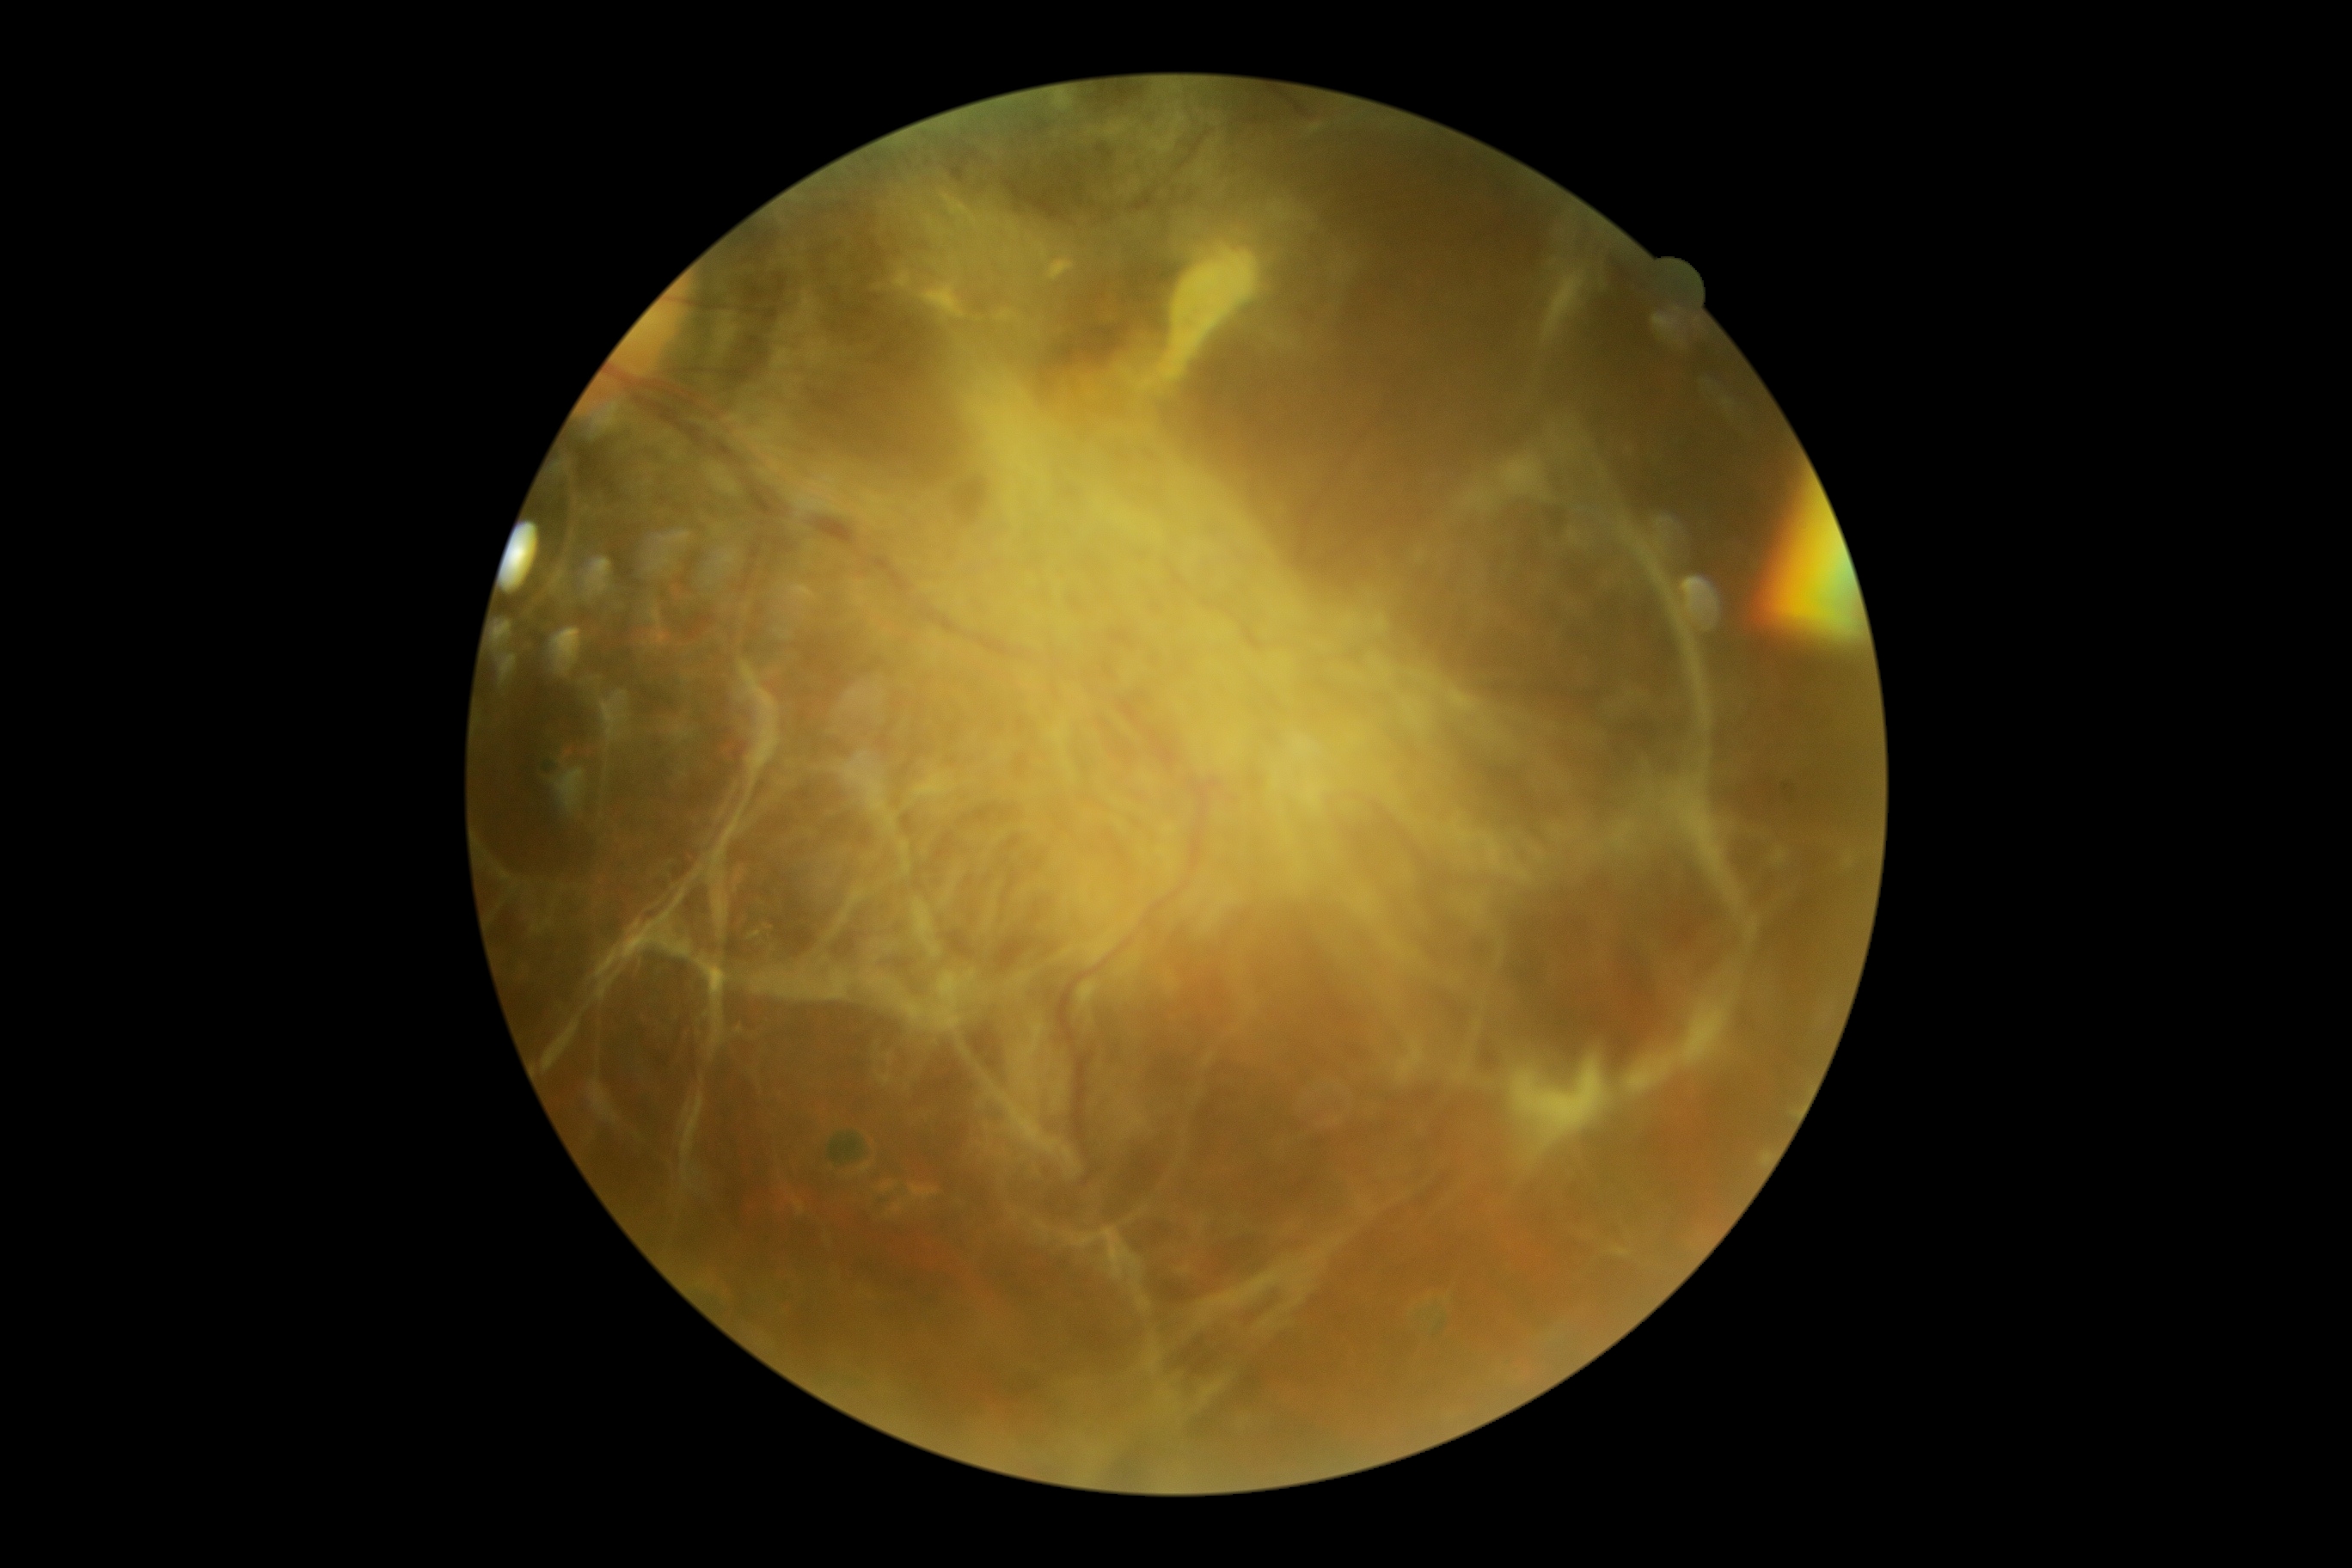 DR grade: 4 (PDR).